Captured with the Phoenix ICON (100° field of view); wide-field fundus photograph of an infant.
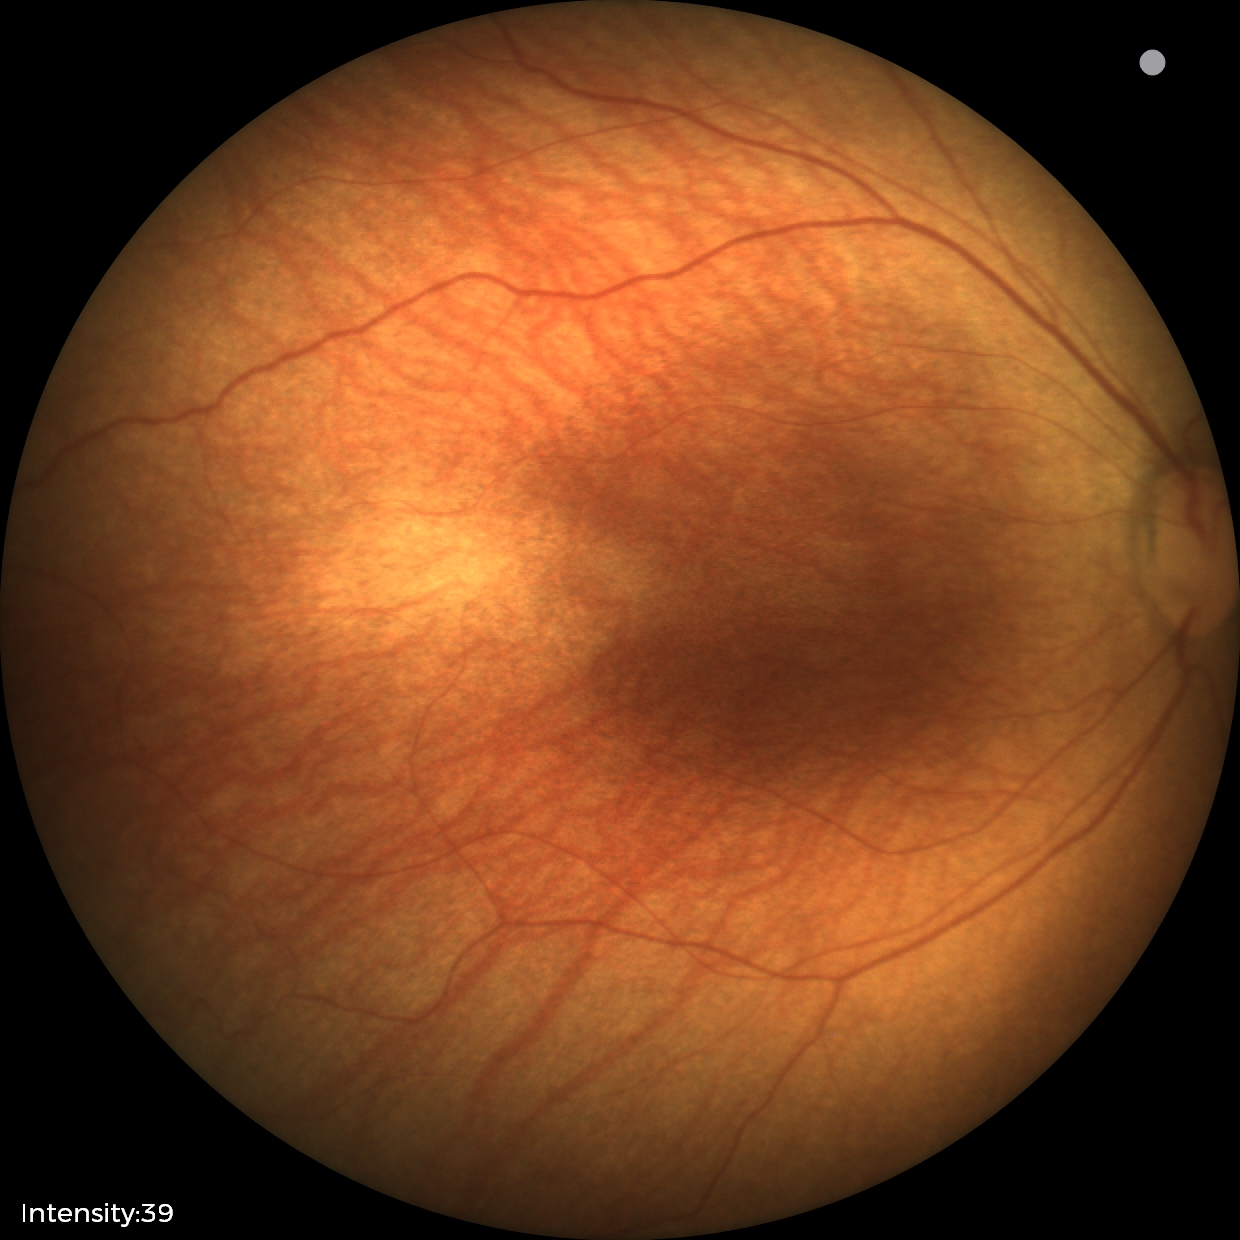

Screening examination with no abnormal retinal findings.